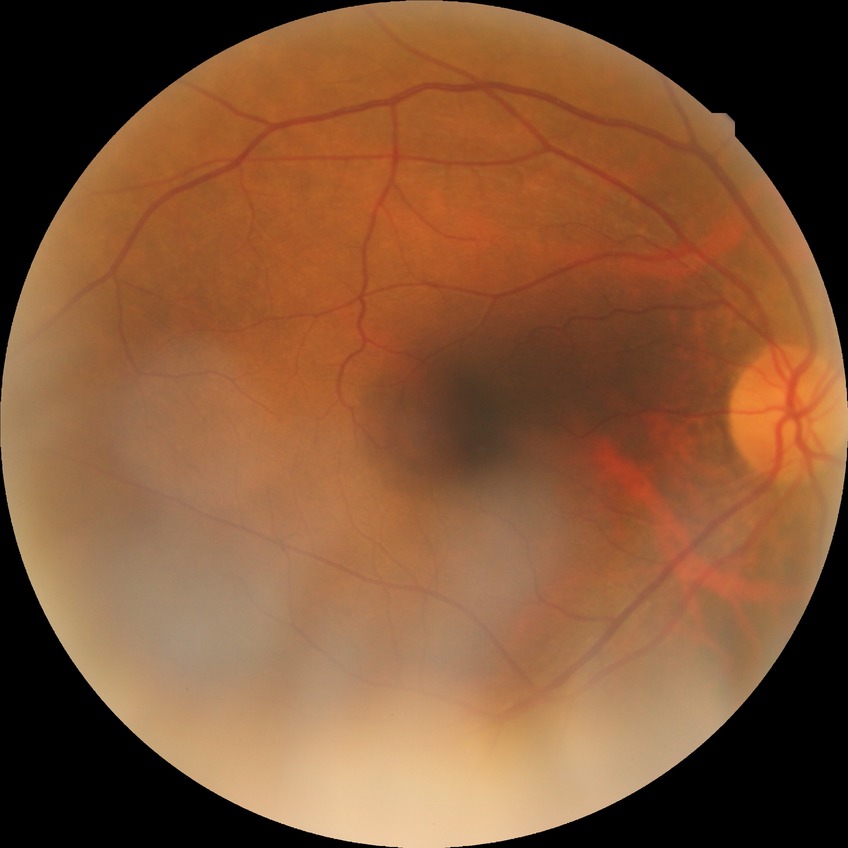 Annotations:
• retinopathy stage: no diabetic retinopathy